Acquired on the Clarity RetCam 3 · 640 by 480 pixels · wide-field fundus image from infant ROP screening: 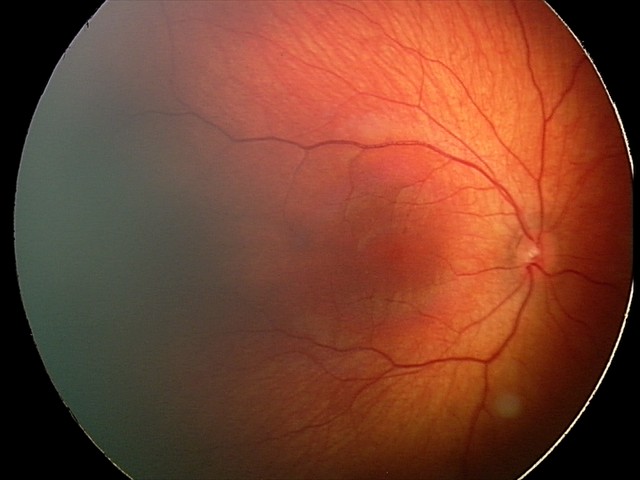 Diagnosis from this screening exam: retinal hemorrhages.